Wide-field contact fundus photograph of an infant. 130° field of view (Clarity RetCam 3). 640 by 480 pixels:
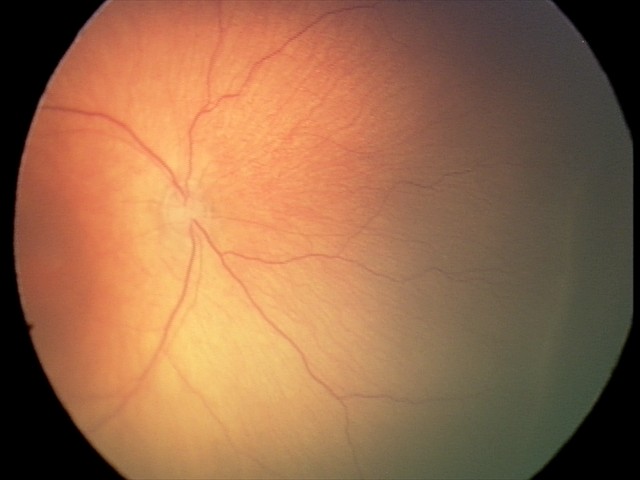

Screening examination consistent with retinopathy of prematurity stage 2.